Wide-field fundus image from infant ROP screening · camera: Clarity RetCam 3 (130° FOV):
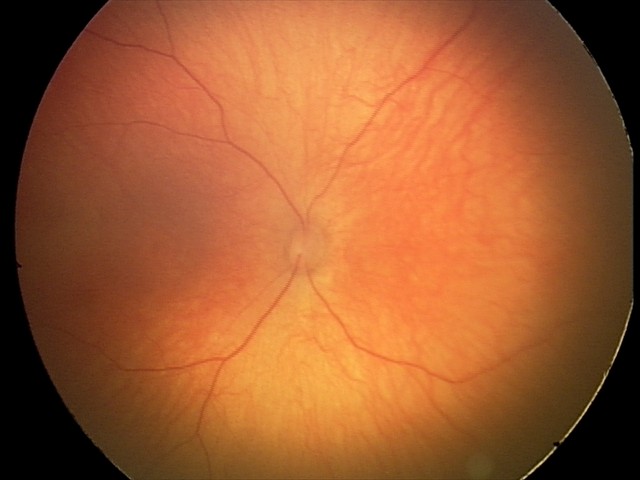 Q: What is the diagnosis from this examination?
A: physiological retinal finding